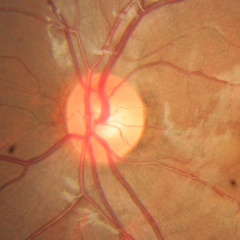
No glaucomatous findings.